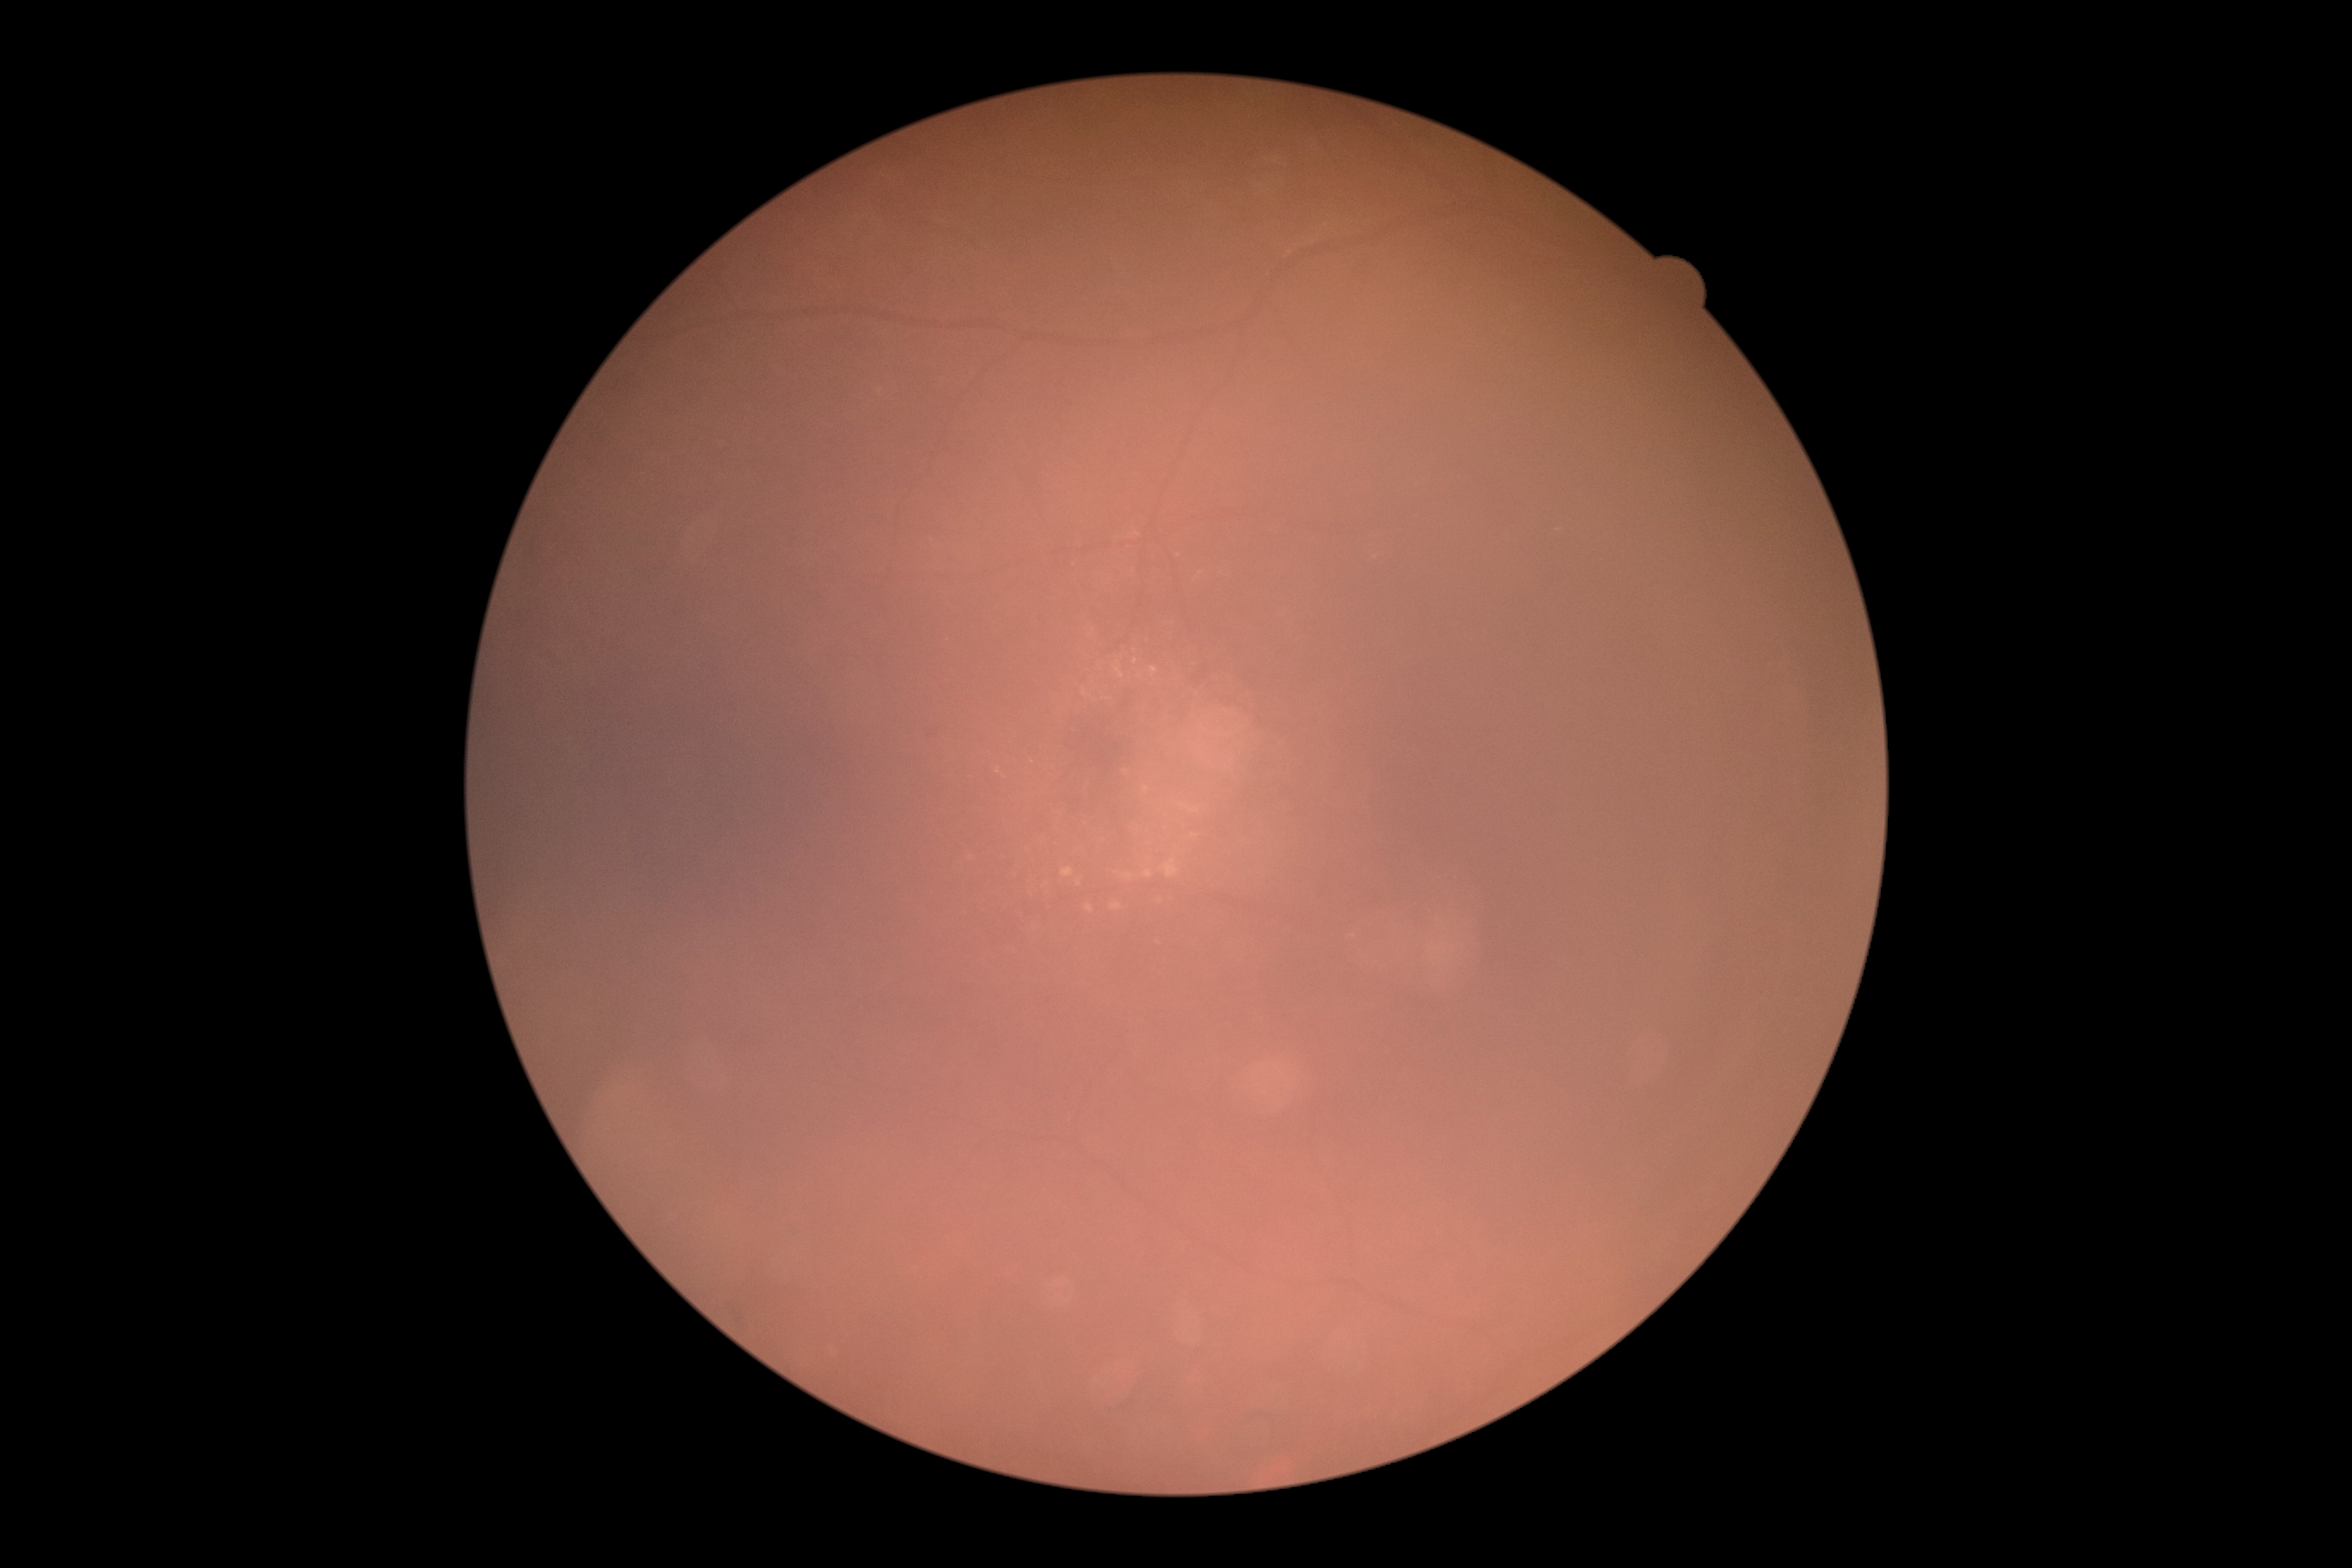 {"dr_grade": "grade 2"}